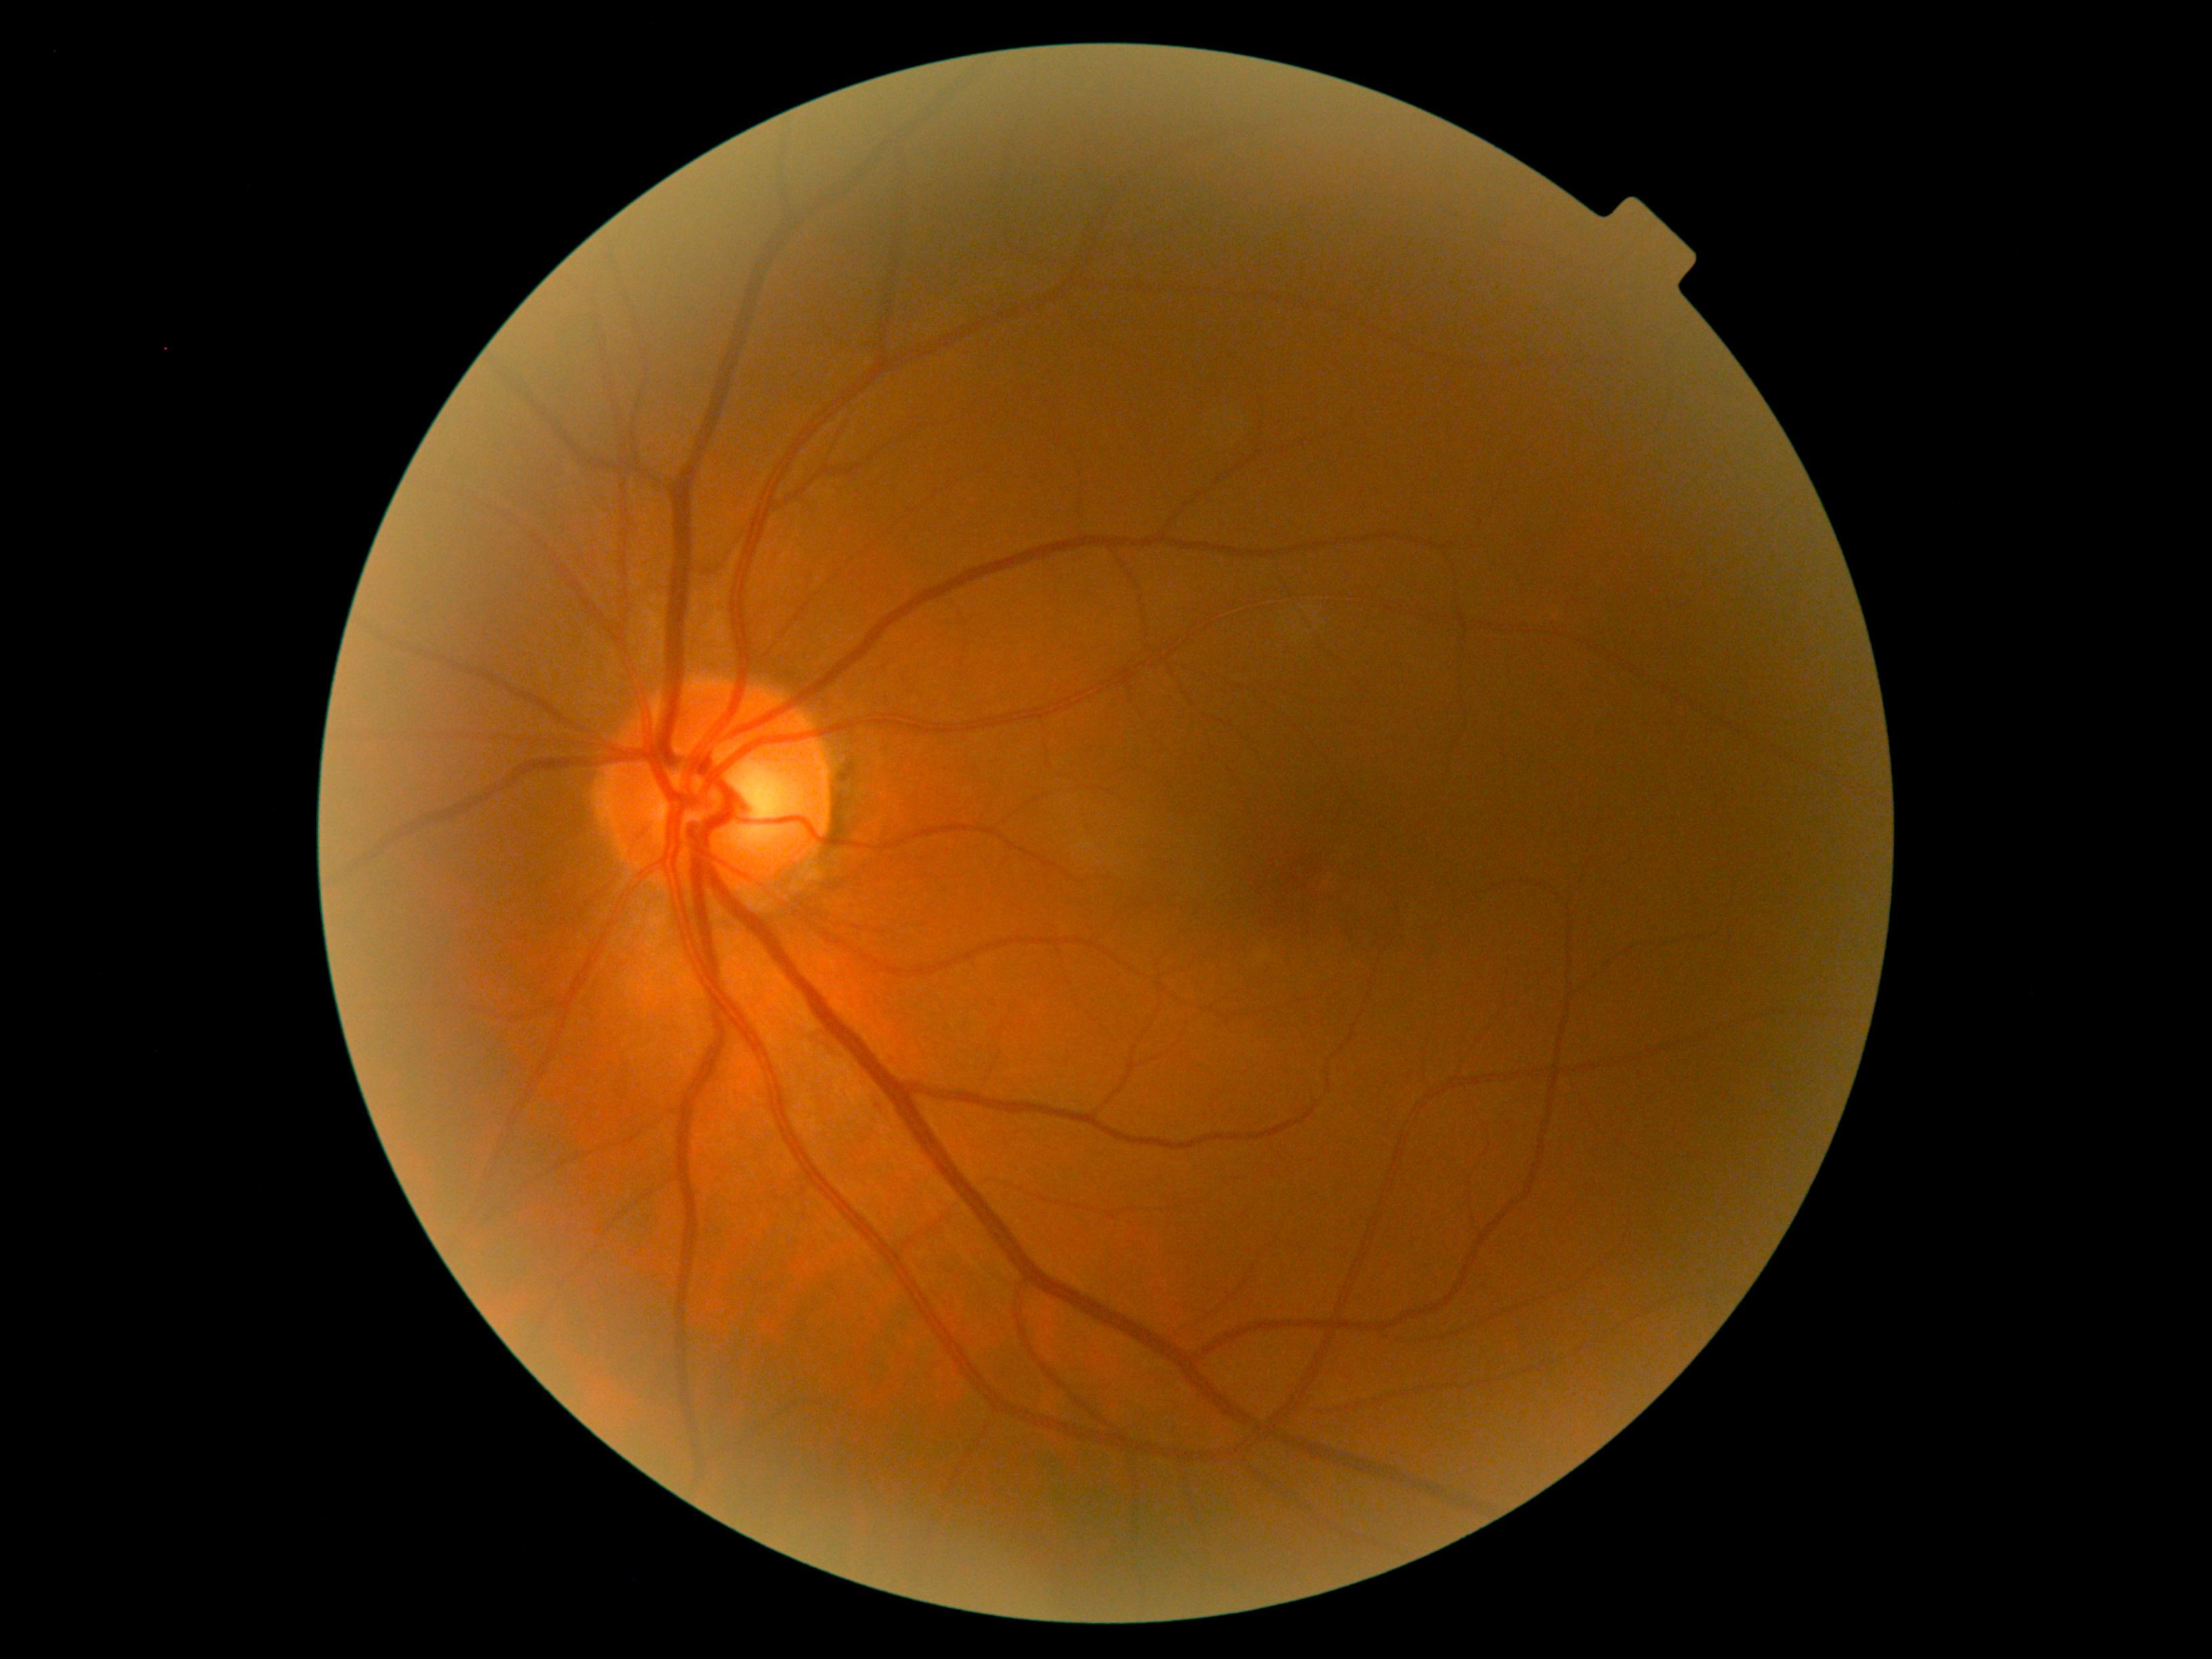 DR grade: 0 (no apparent retinopathy).